CFP
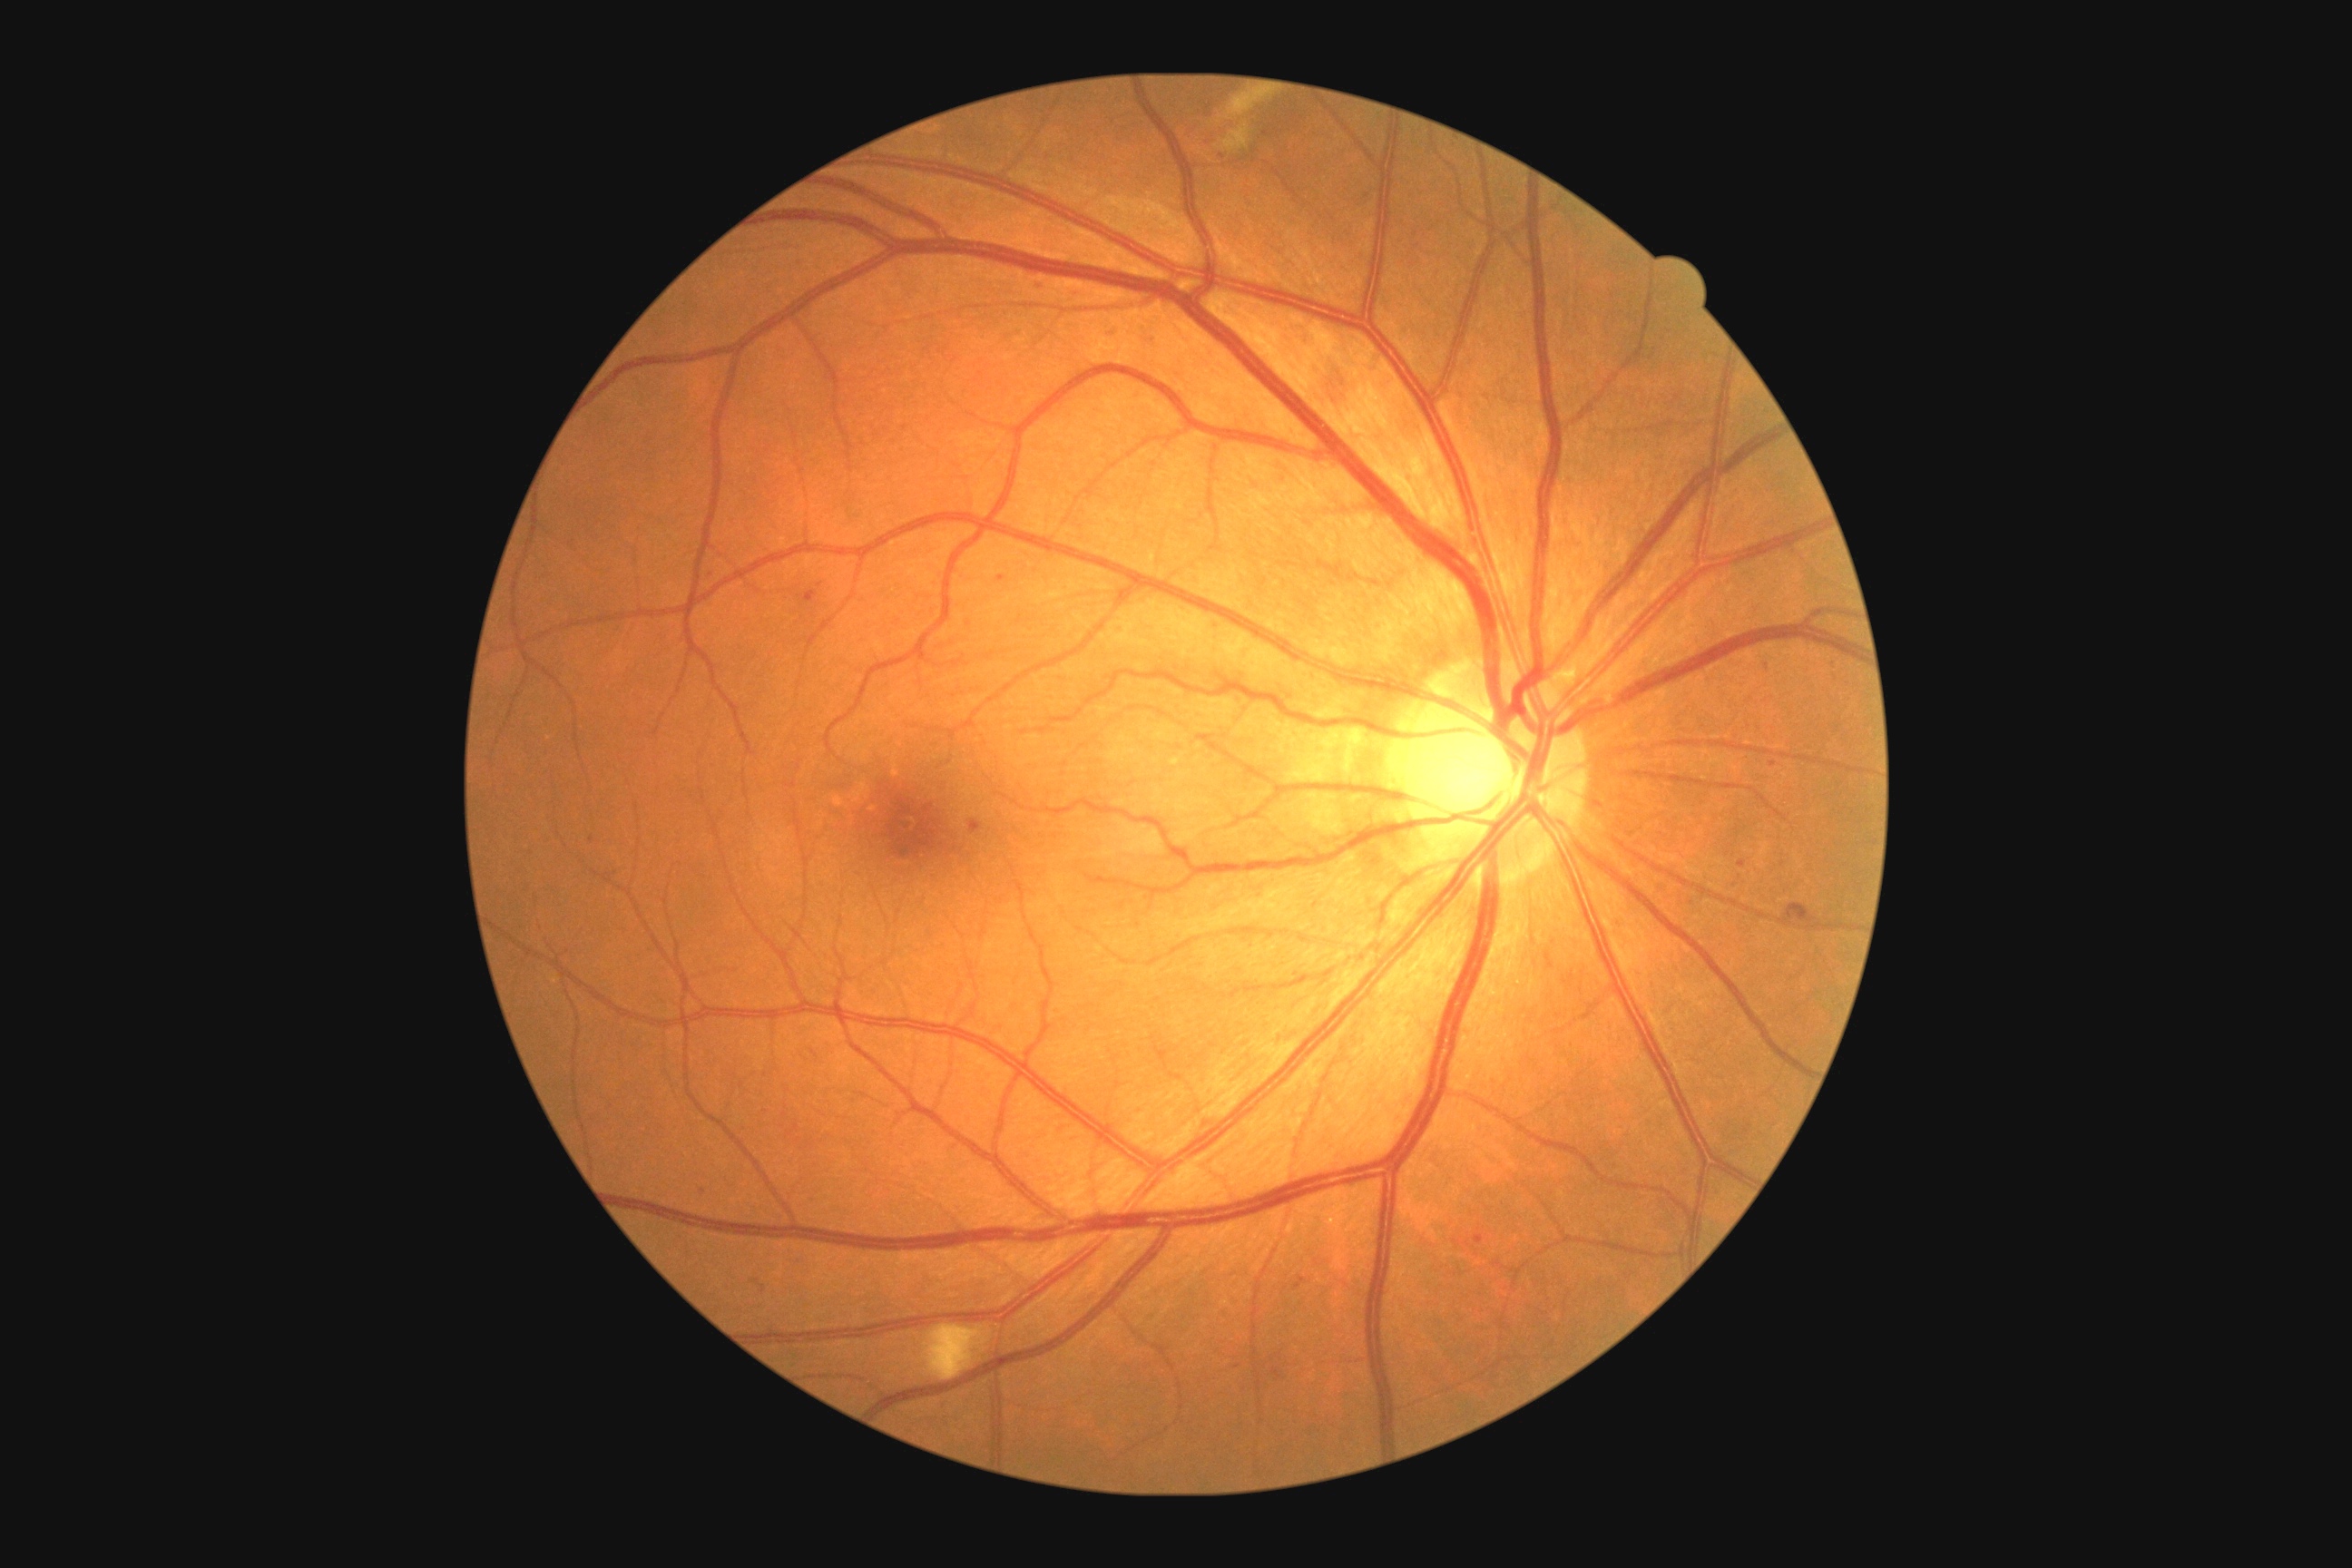

partial: true
dr_grade: 2
lesions:
  ma:
    - x1=1271, y1=1369, x2=1282, y2=1378
    - x1=803, y1=591, x2=818, y2=603
    - x1=1827, y1=663, x2=1836, y2=669
    - x1=761, y1=1286, x2=767, y2=1295
    - x1=1035, y1=280, x2=1043, y2=288
    - x1=1108, y1=328, x2=1115, y2=337
  ma_small_approx:
    - (703,1191)
    - (1266,134)
    - (1222,157)
    - (1771,668)